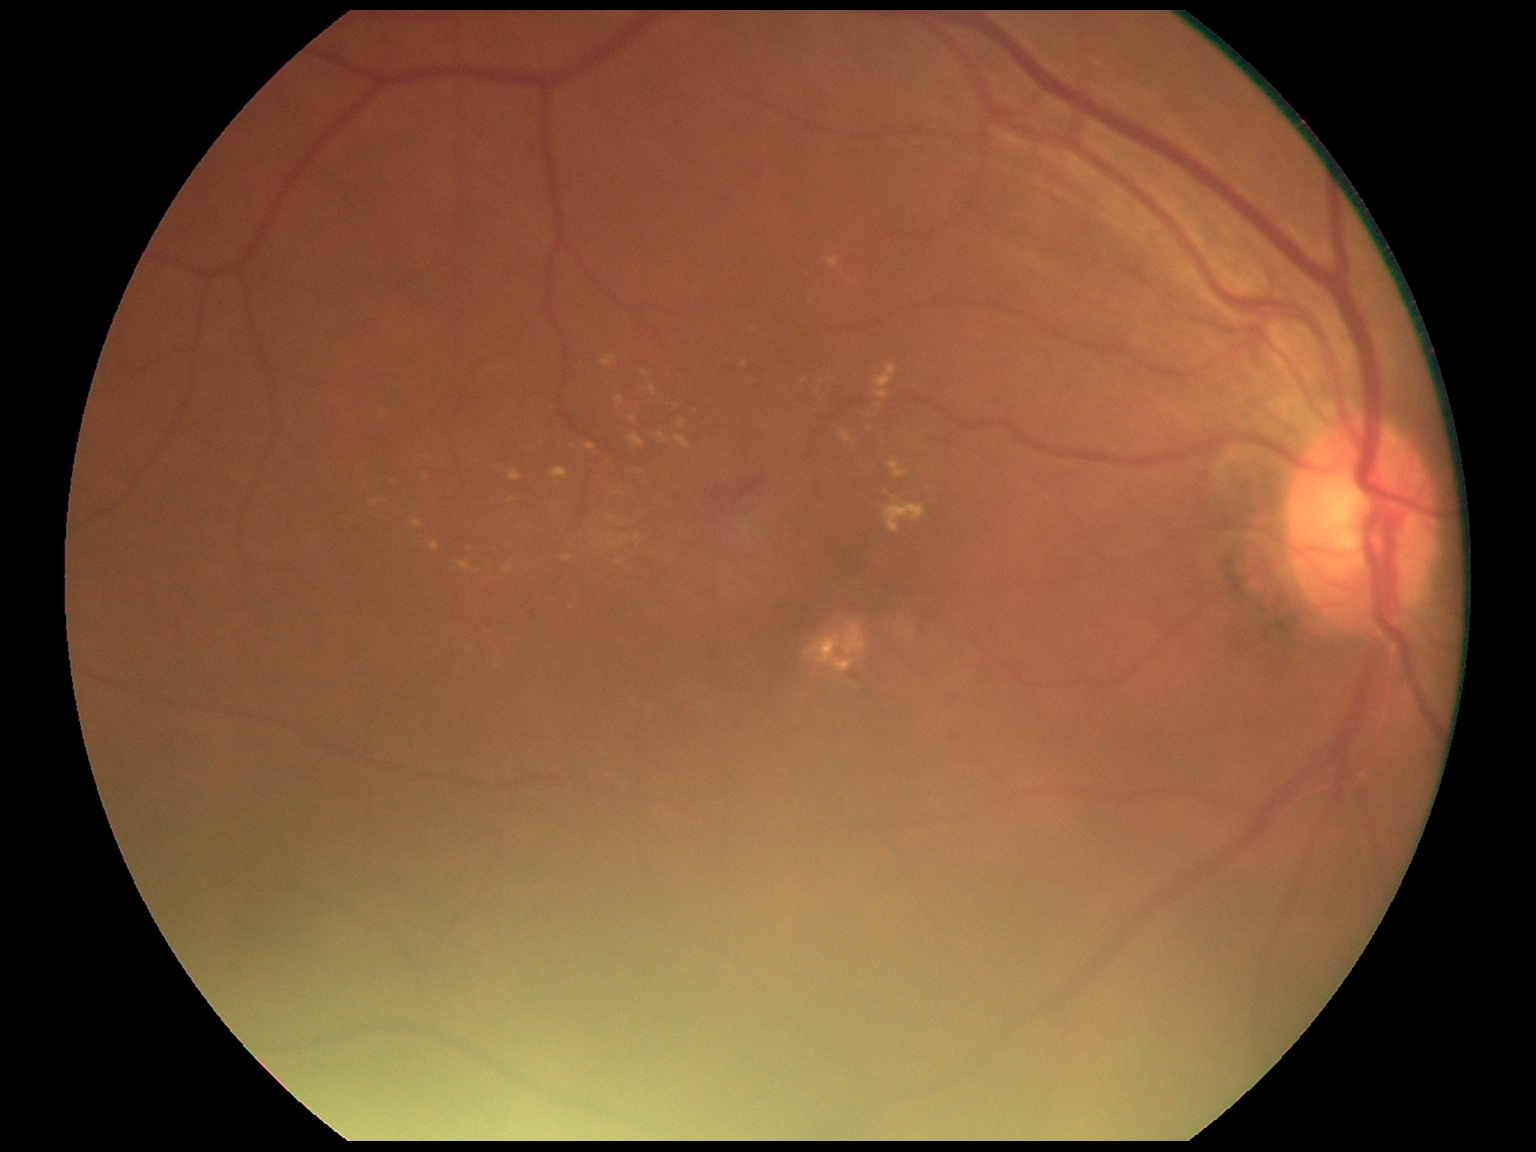

Annotations:
* DR severity: grade 2